848x848px · modified Davis classification · 45-degree field of view: 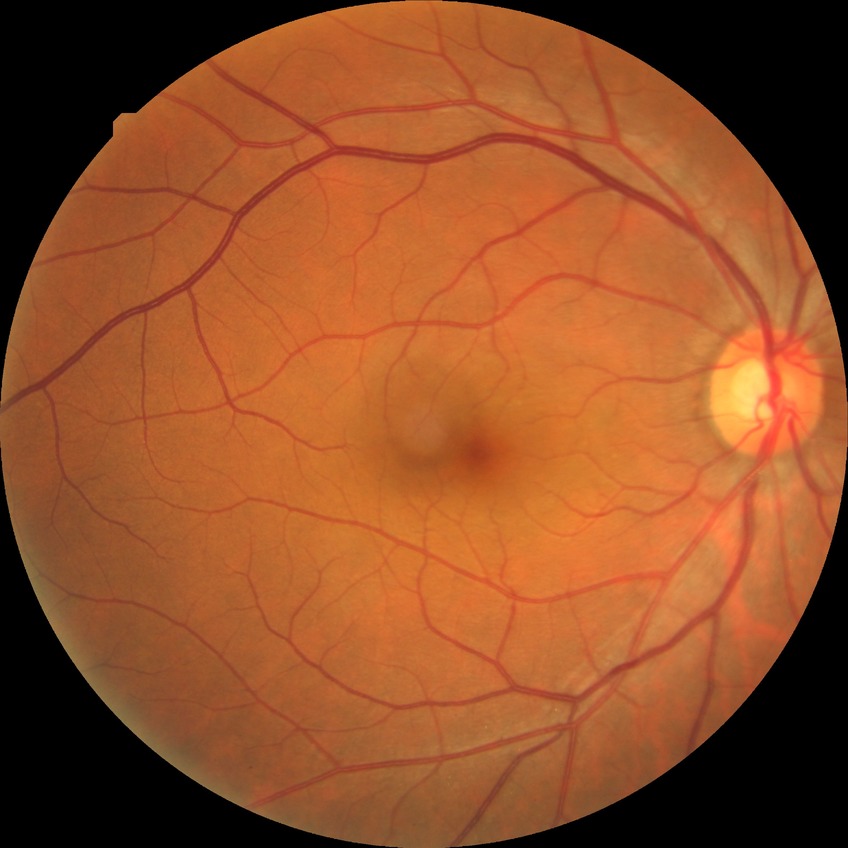

Davis grading: no diabetic retinopathy.